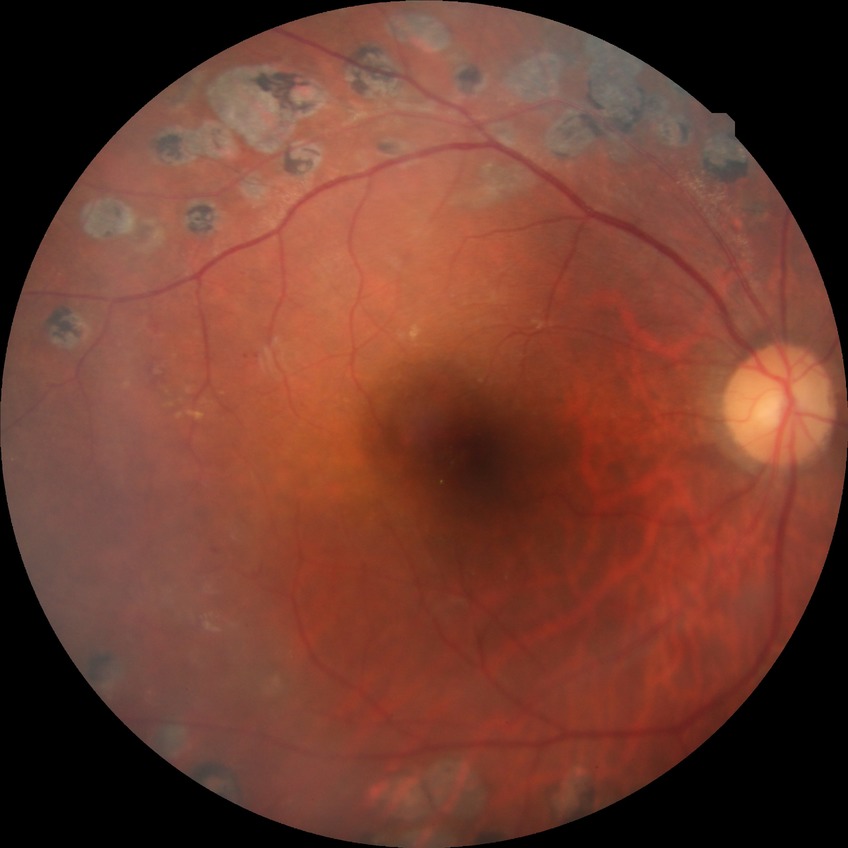

Assessment:
- diabetic retinopathy grade — proliferative diabetic retinopathy